45° FOV; modified Davis classification.
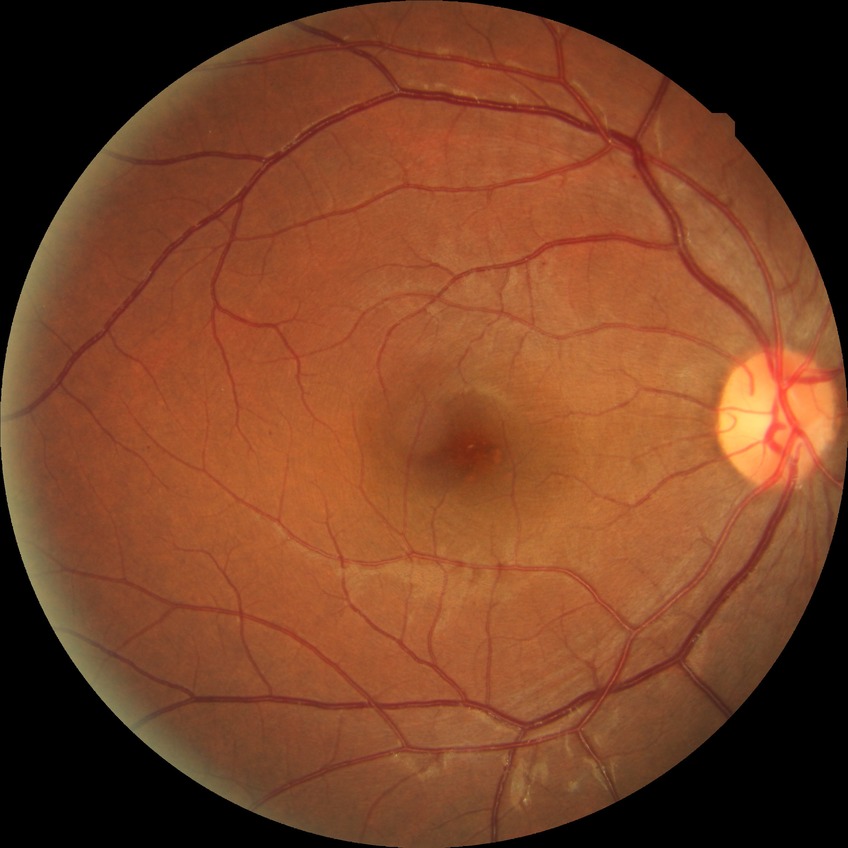 diabetic retinopathy (DR) = simple diabetic retinopathy (SDR)